Davis DR grading. 45 degree fundus photograph:
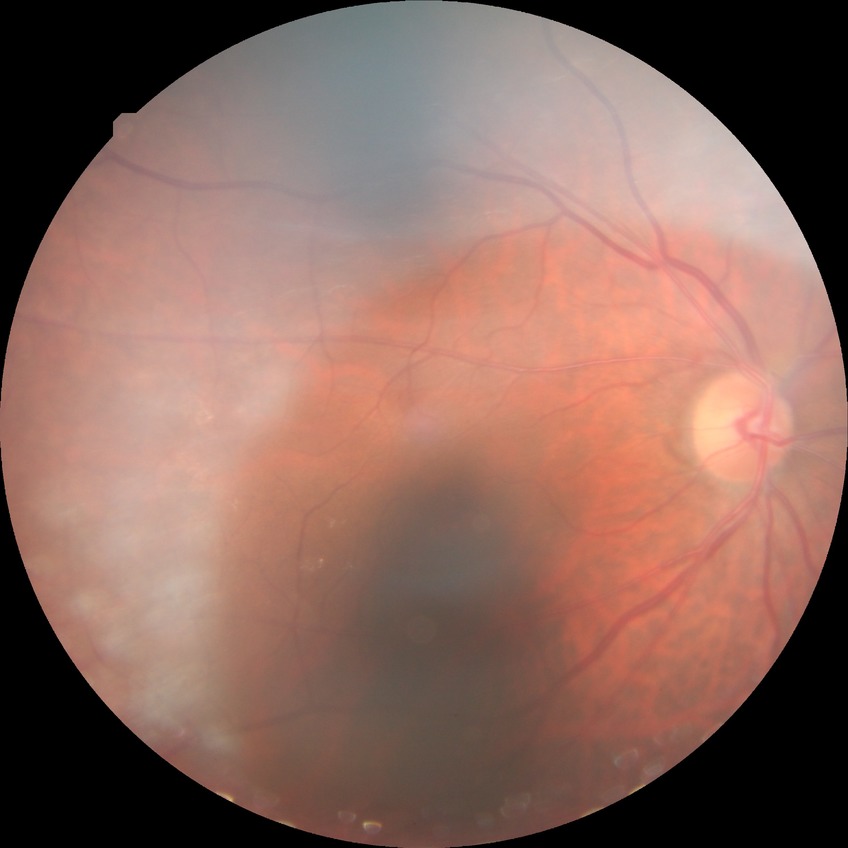

{"davis_grade": "NDR (no diabetic retinopathy)"}